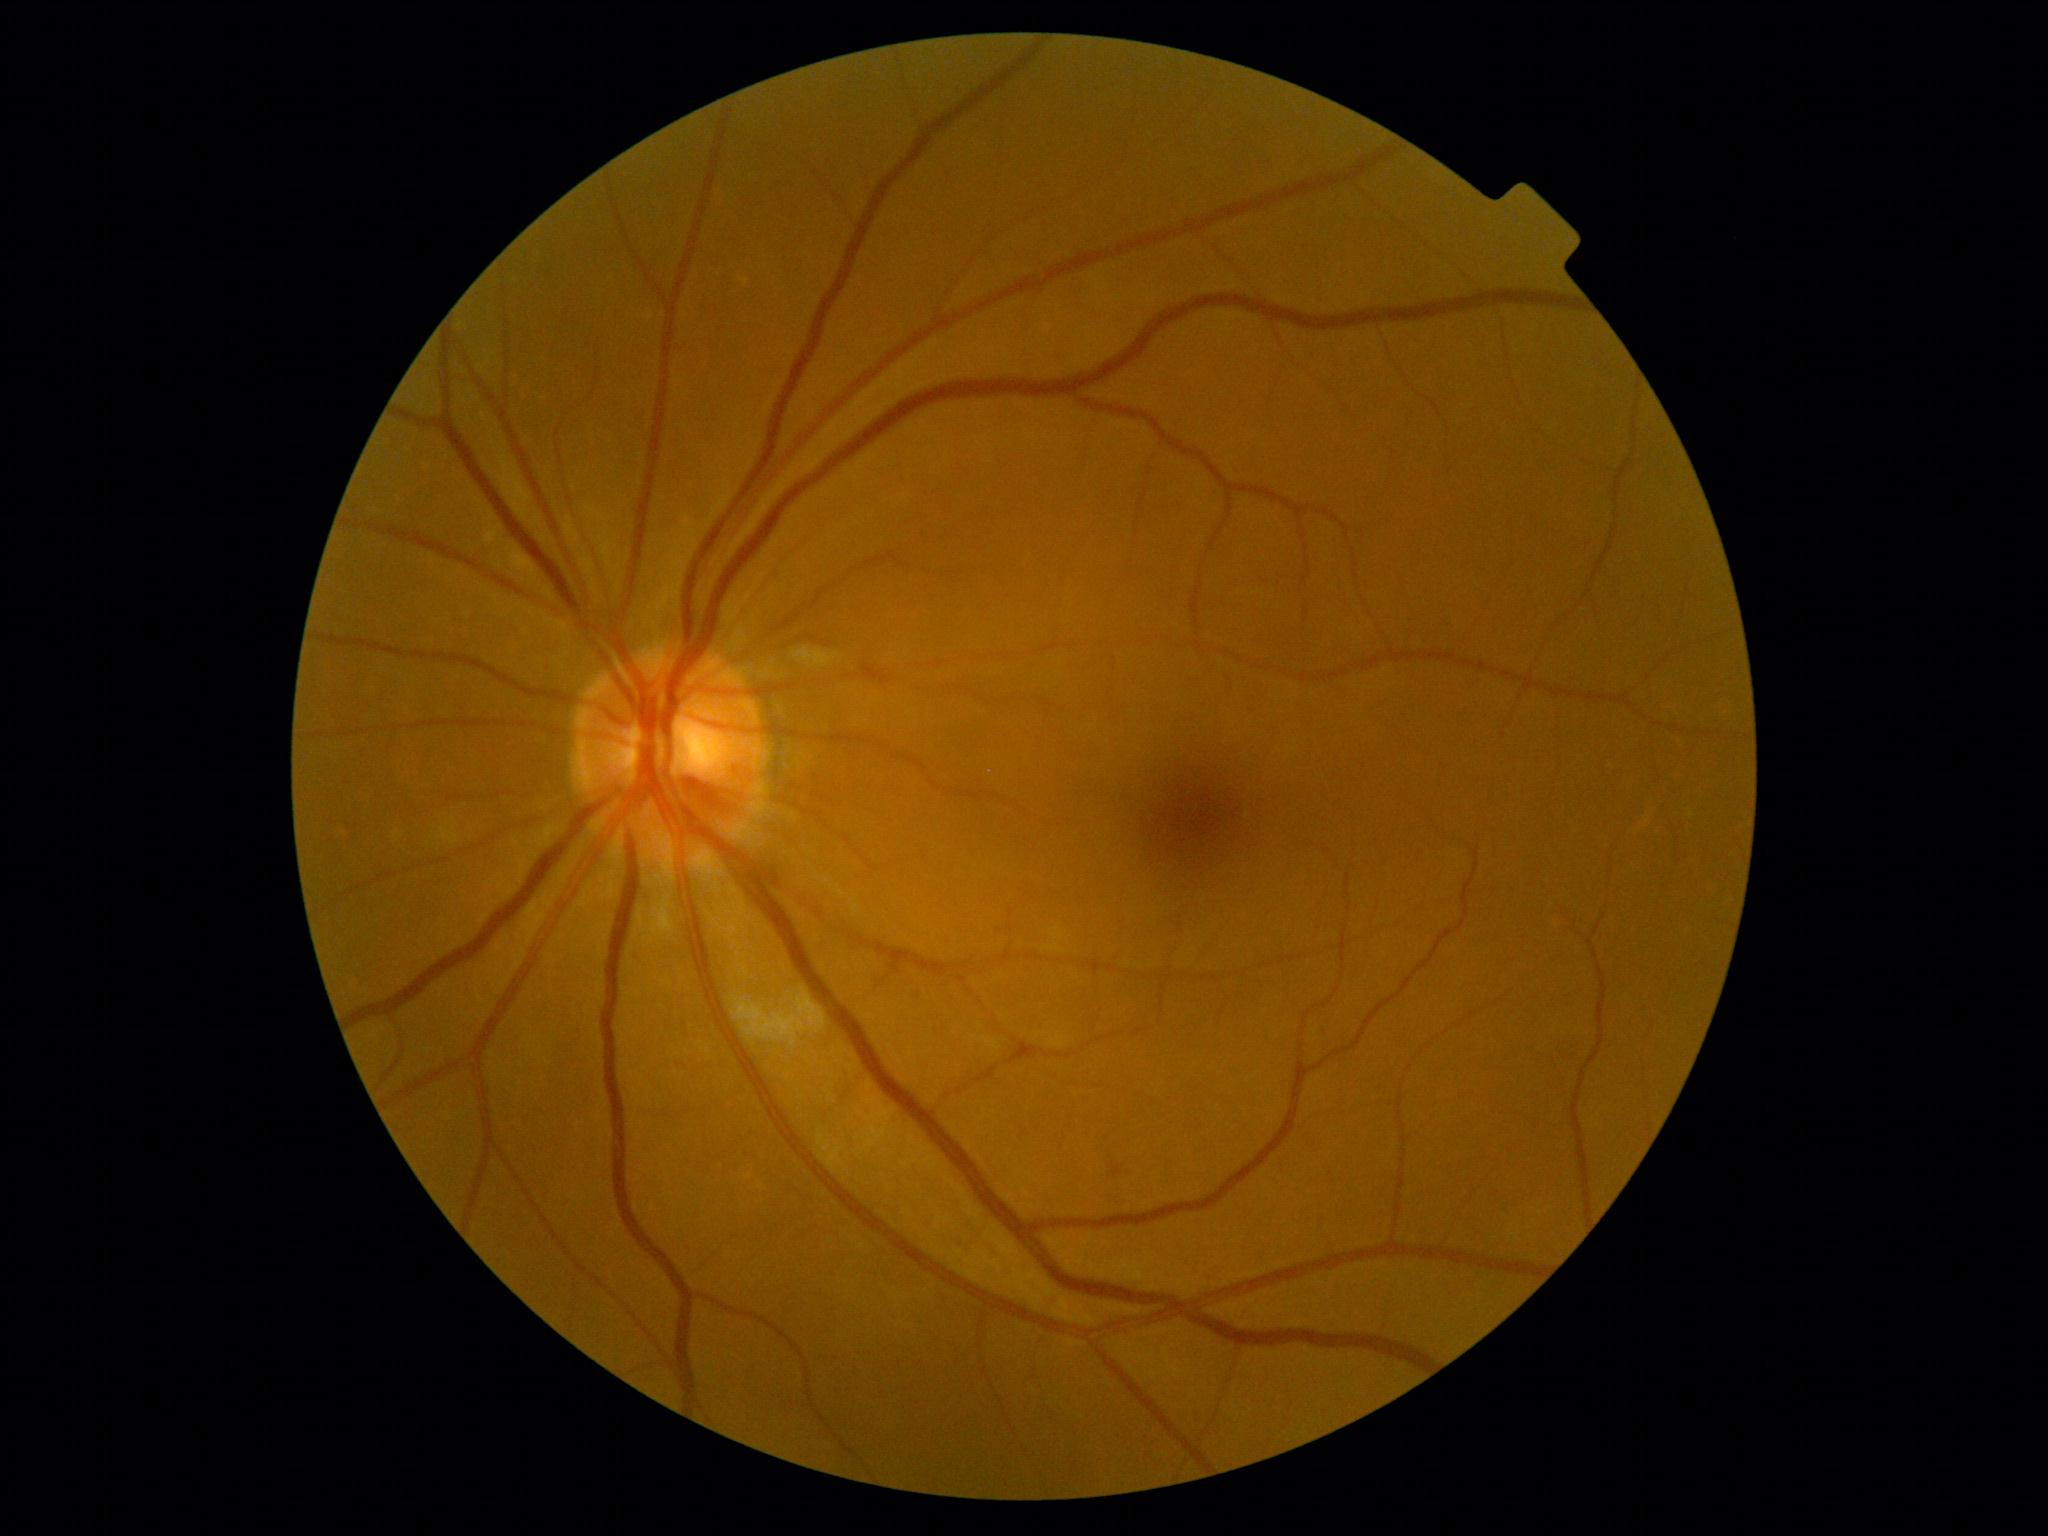
DR stage@moderate NPDR (grade 2).